FOV: 45 degrees, CFP
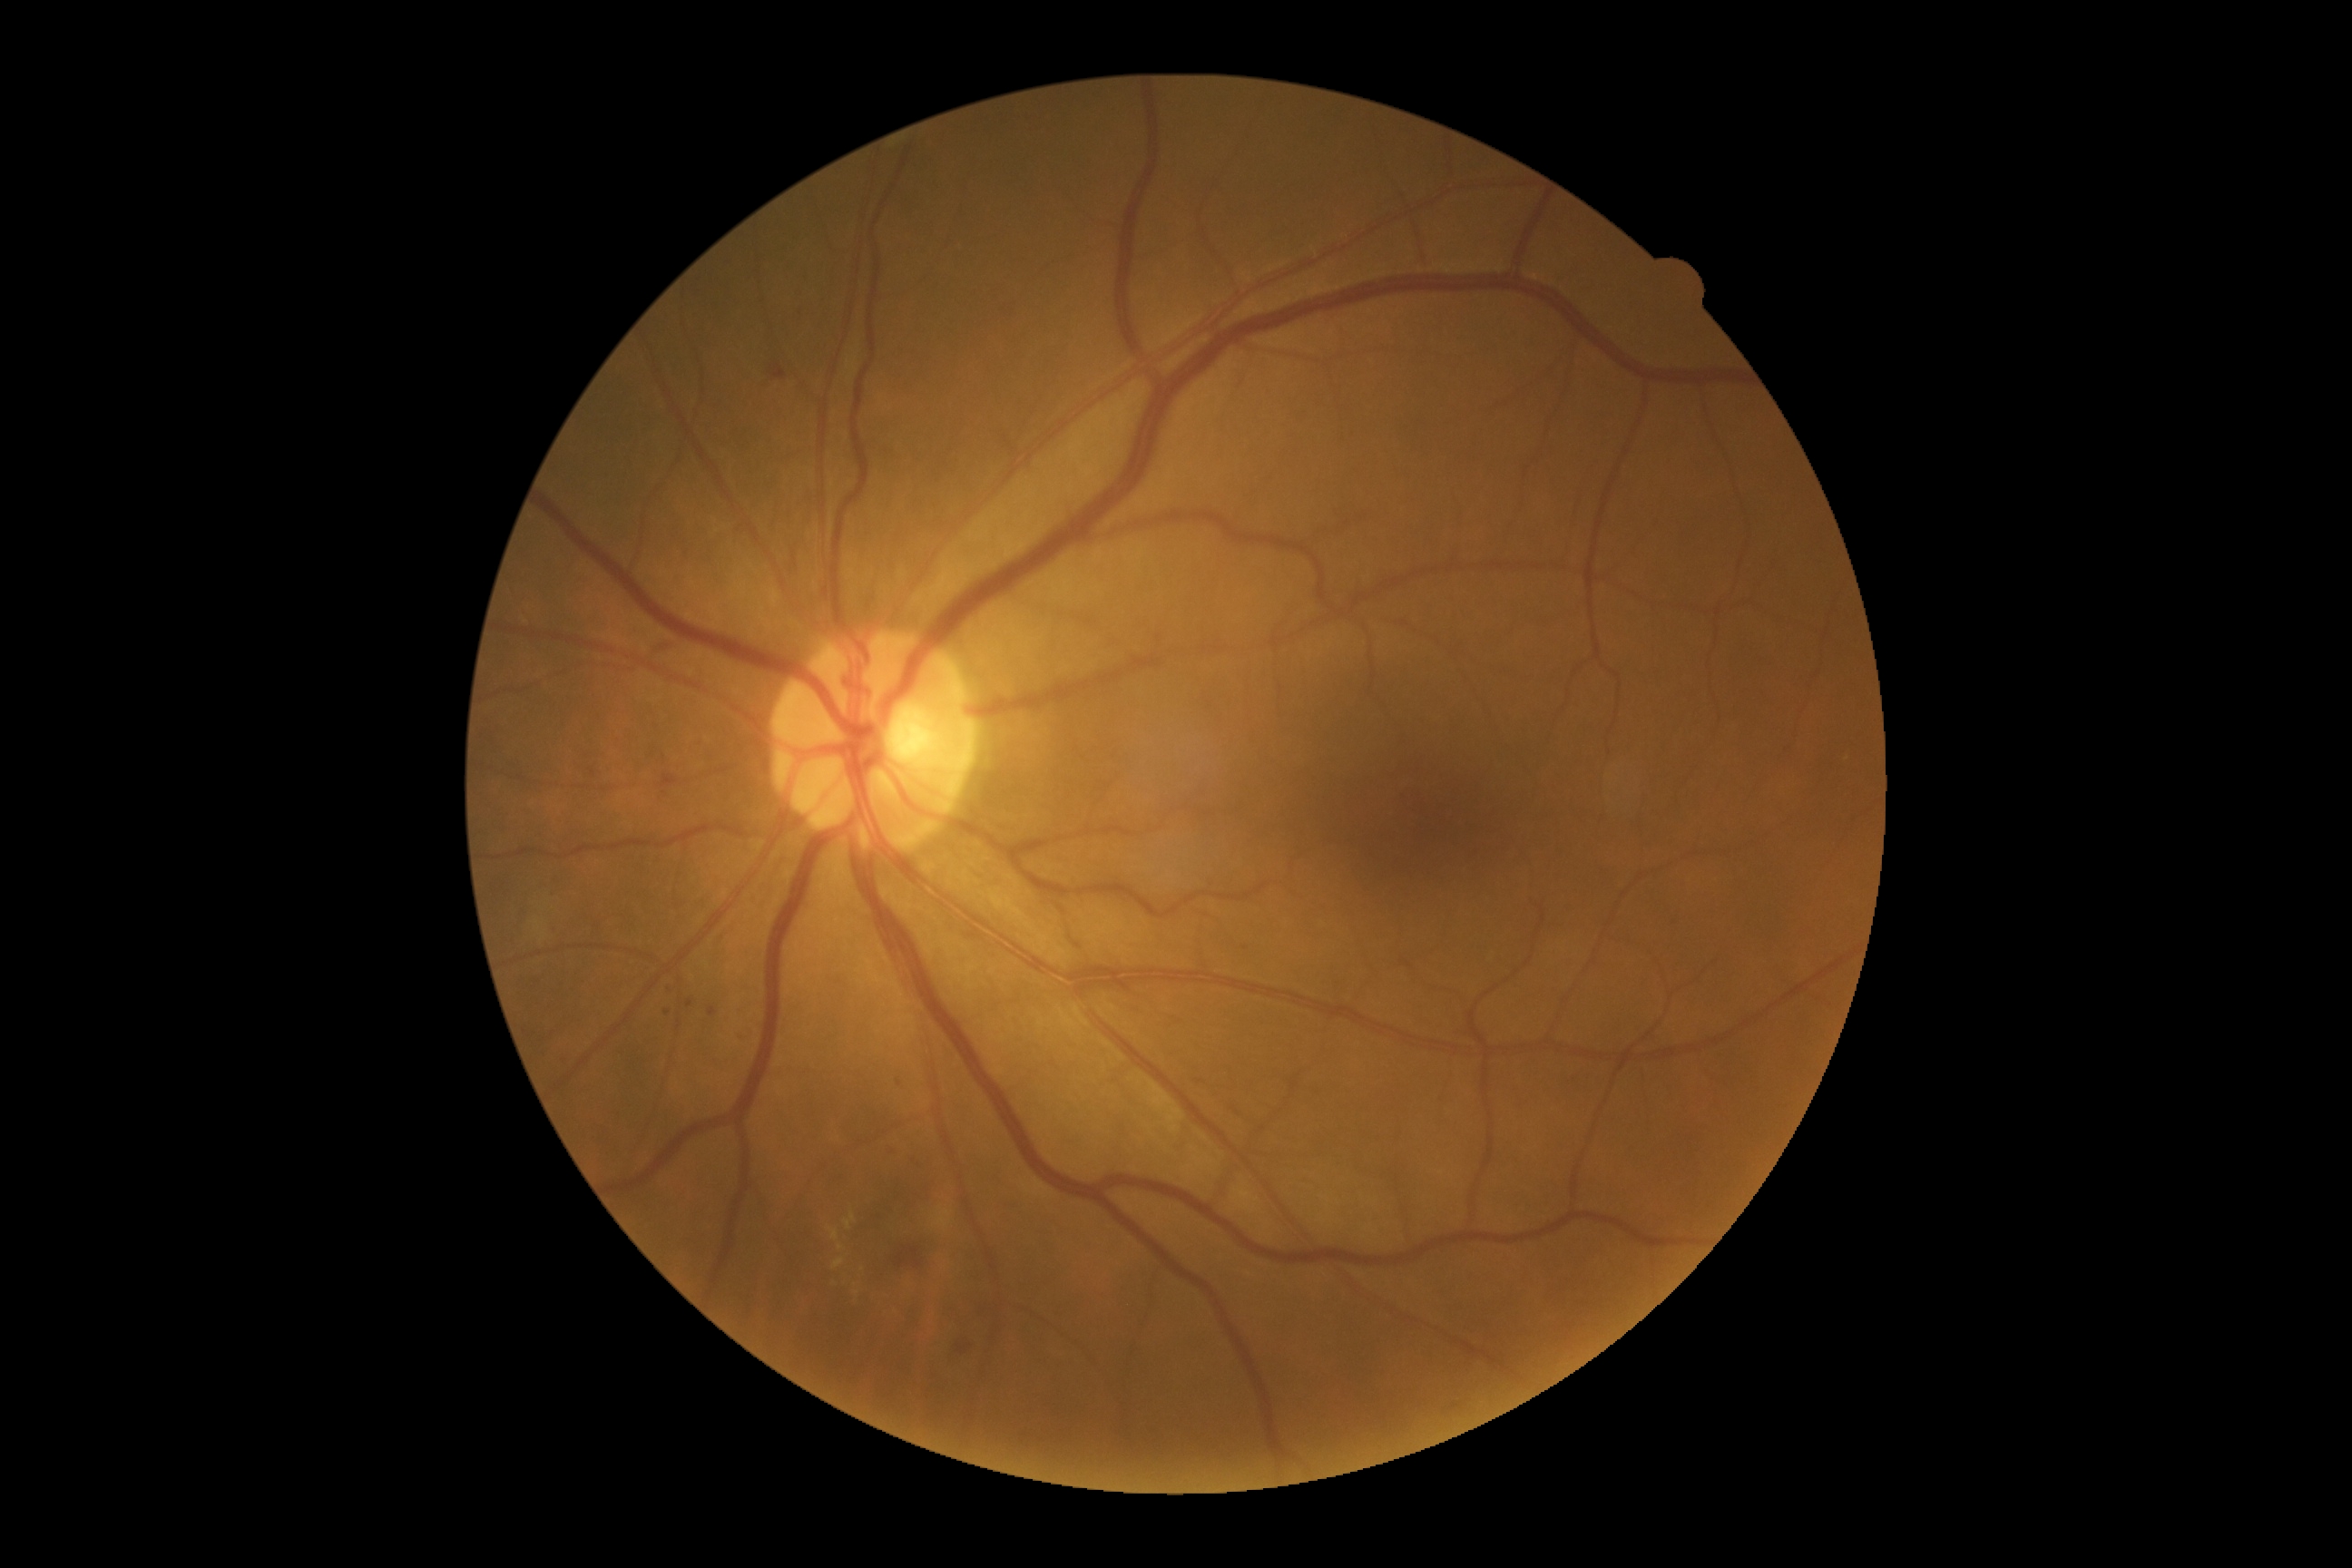
diabetic retinopathy (DR) = moderate non-proliferative diabetic retinopathy (grade 2).